Infant wide-field retinal image.
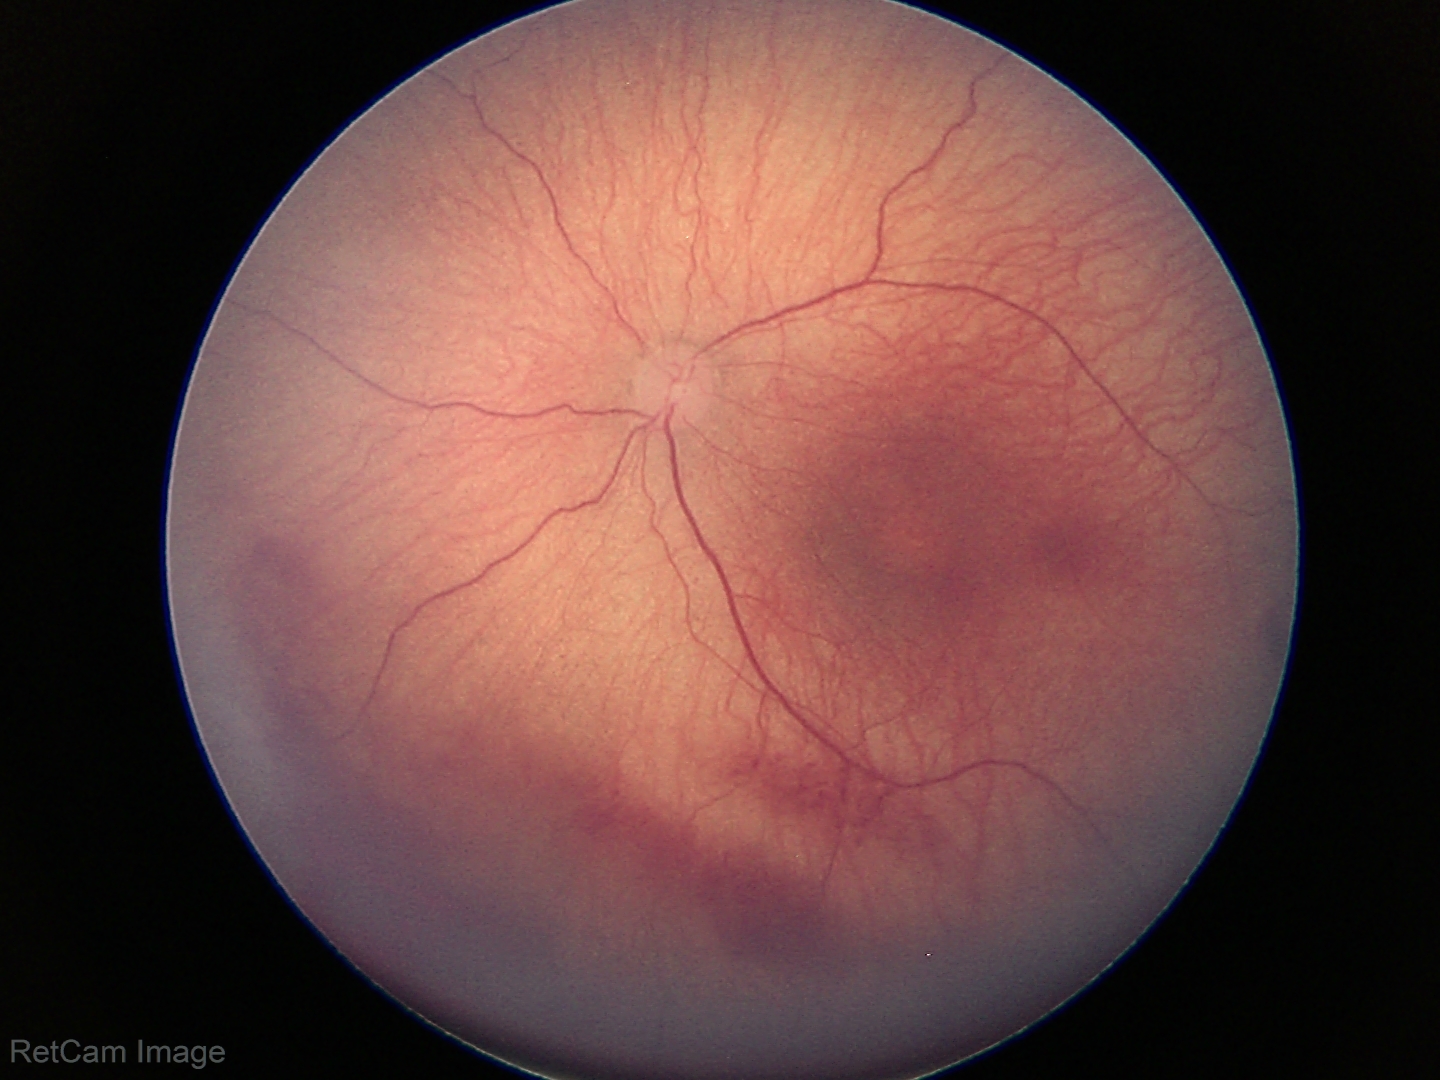

Impression: retinopathy of prematurity stage 1.